Phoenix ICON, 100° FOV; wide-field contact fundus photograph of an infant:
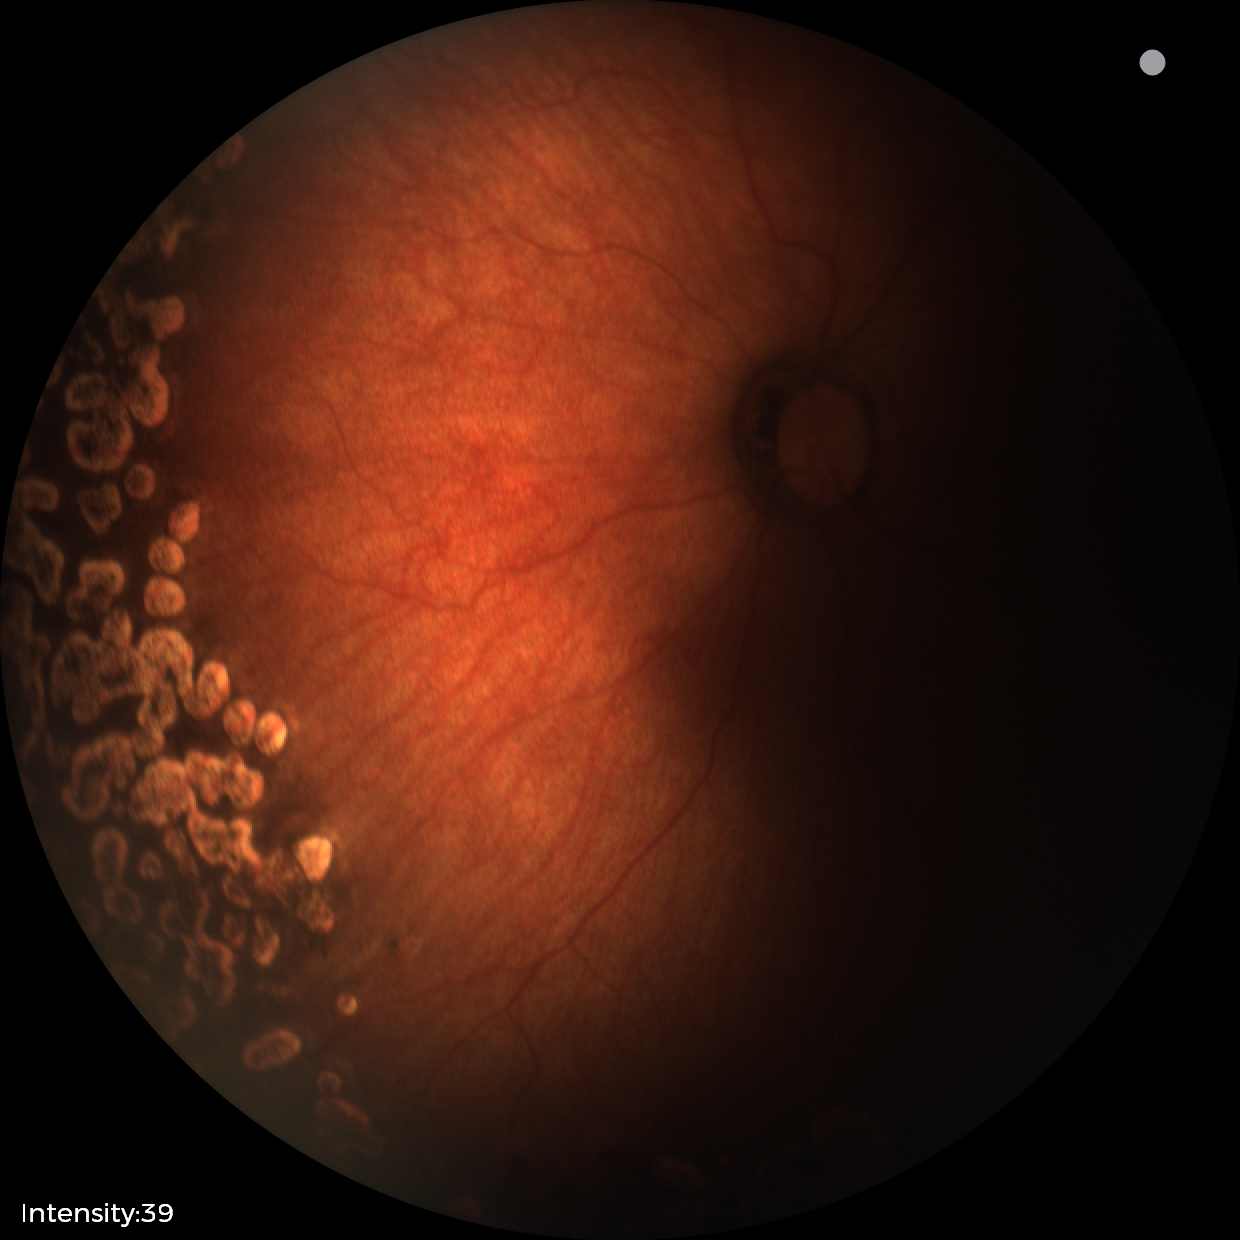

Q: Is plus disease present?
A: no plus disease
Q: What is the diagnosis from this examination?
A: status post ROP